63 years old. Sex: male. Autorefraction: sphere +2.25 D, cylinder -1.25 D, axis 107°. Intraocular pressure (IOP) 12 mmHg:
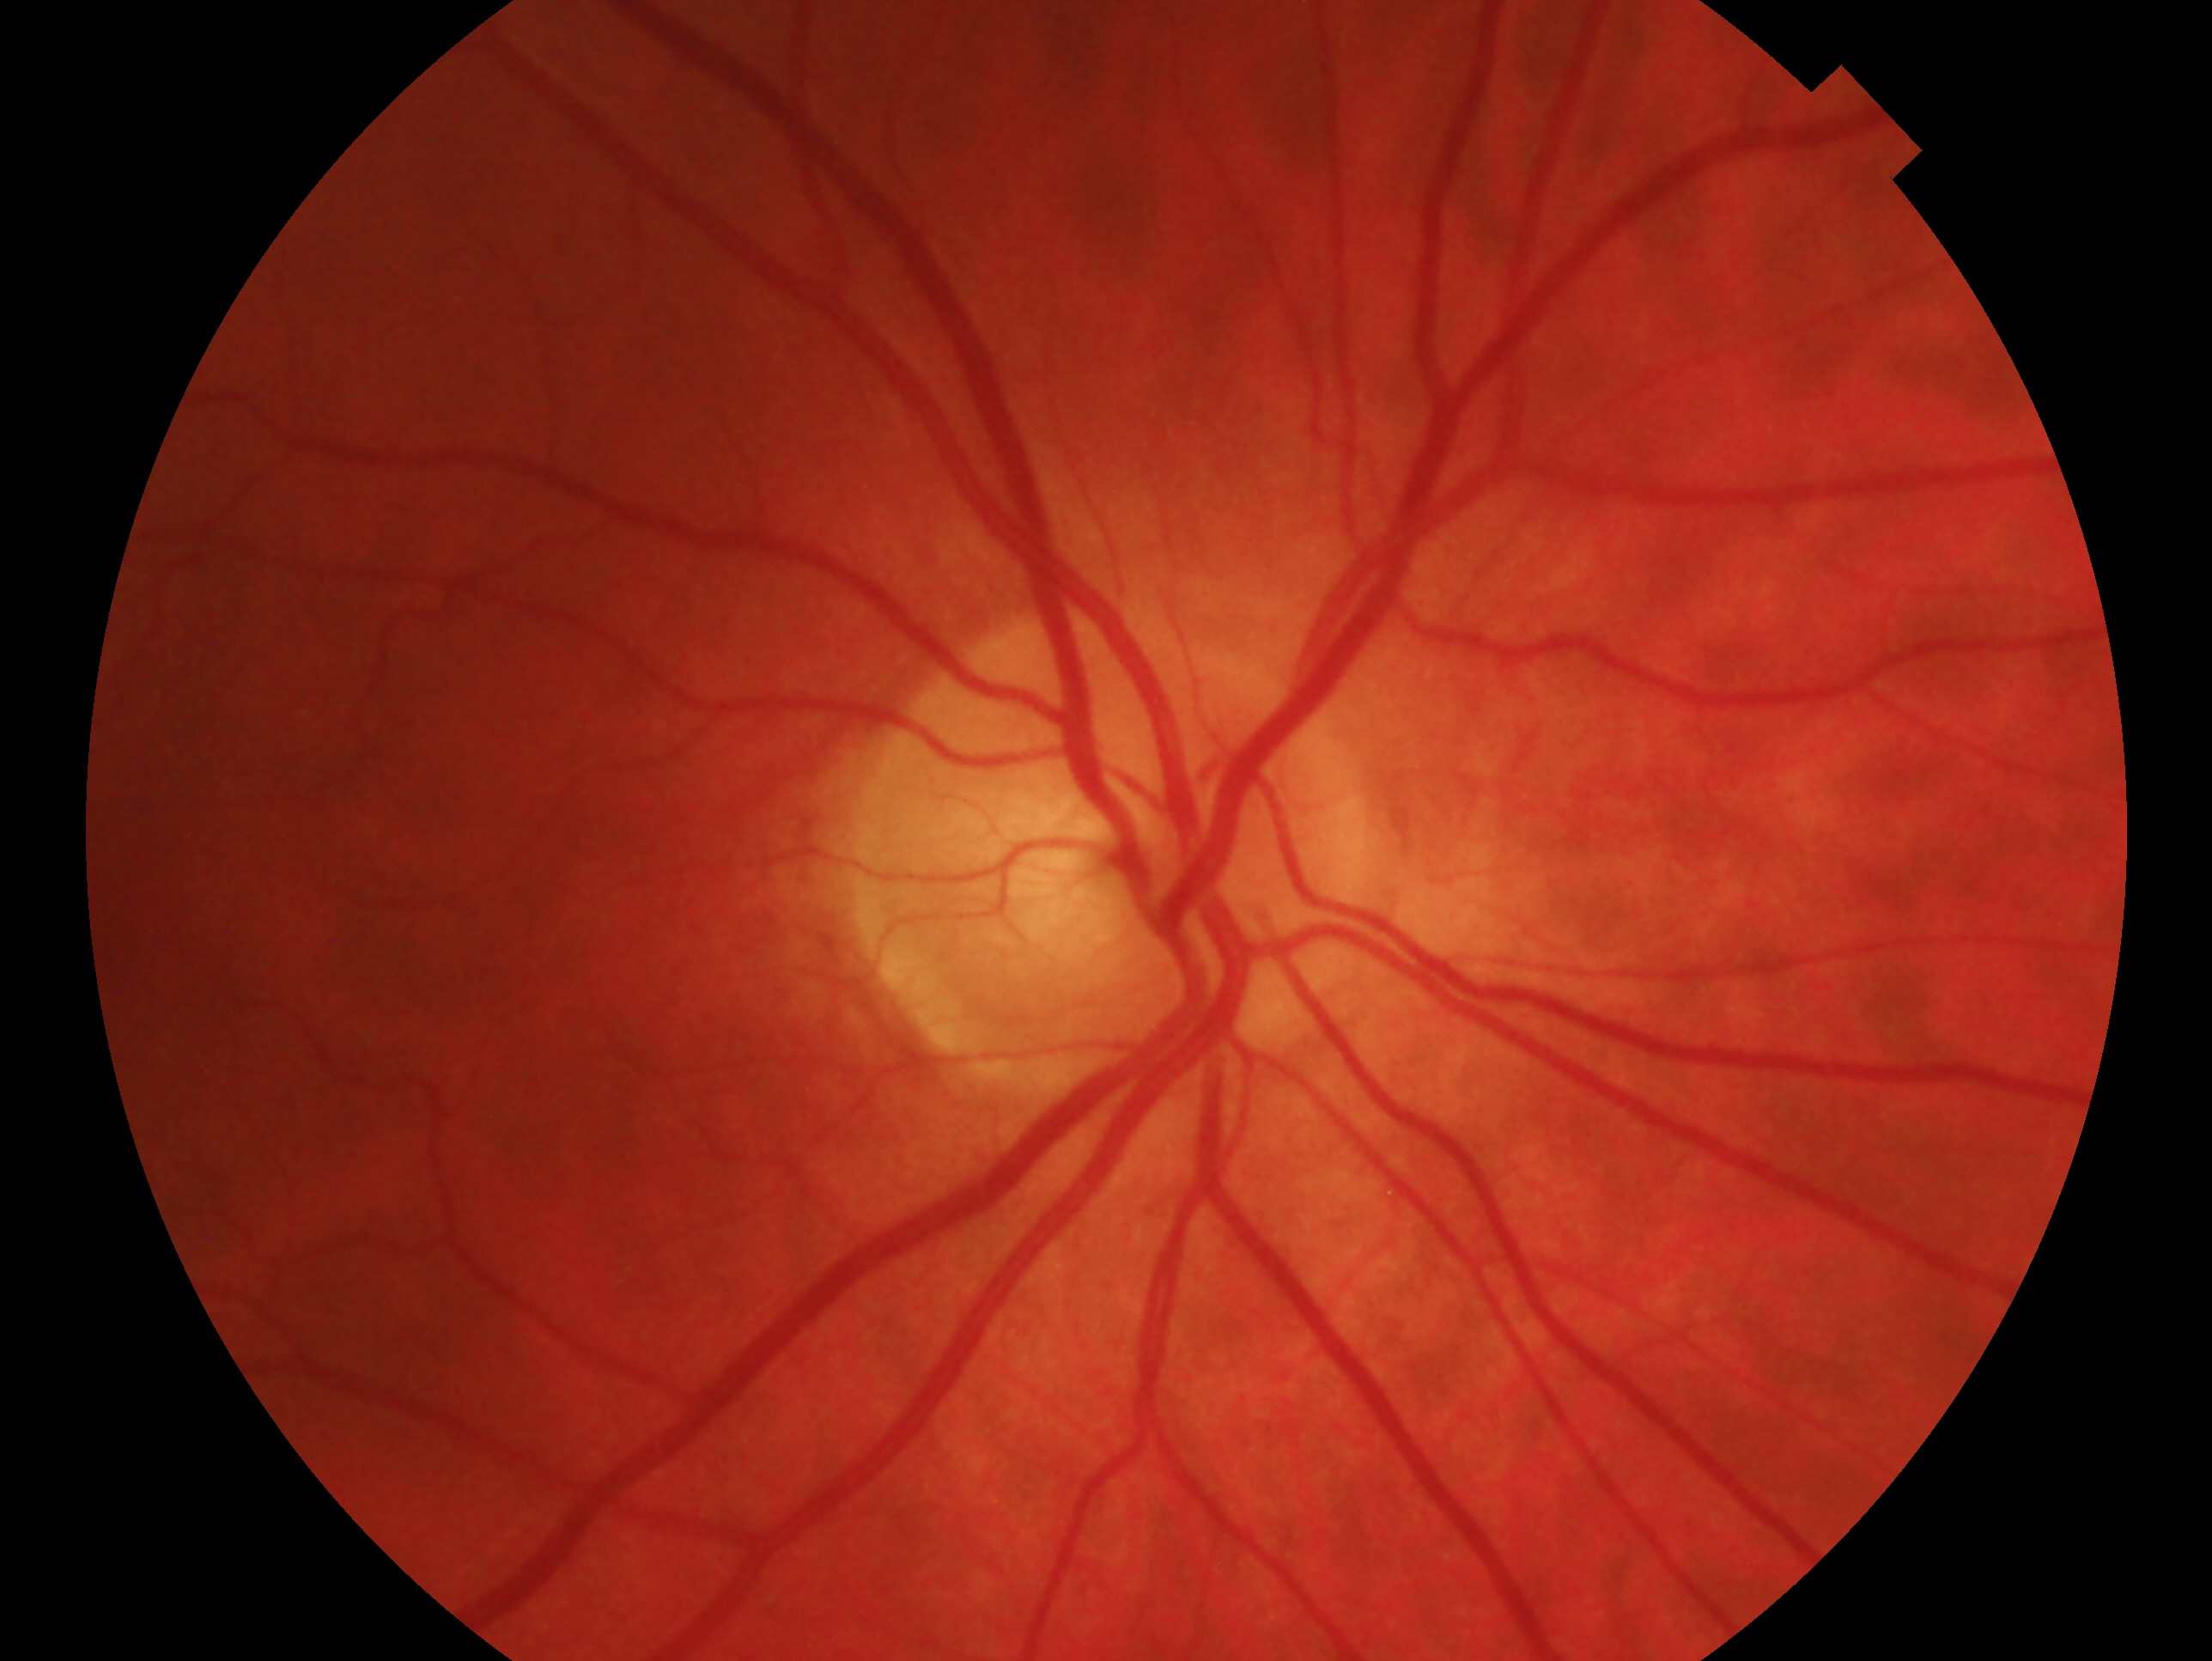
Glaucoma diagnosis — no glaucomatous findings. This is the right eye.